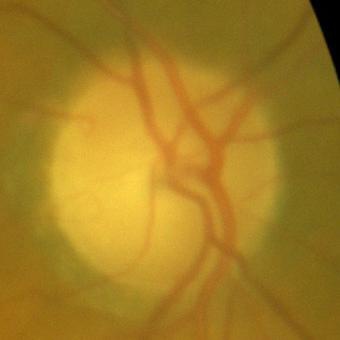

Assessment: no glaucomatous findings.